DR severity per modified Davis staging
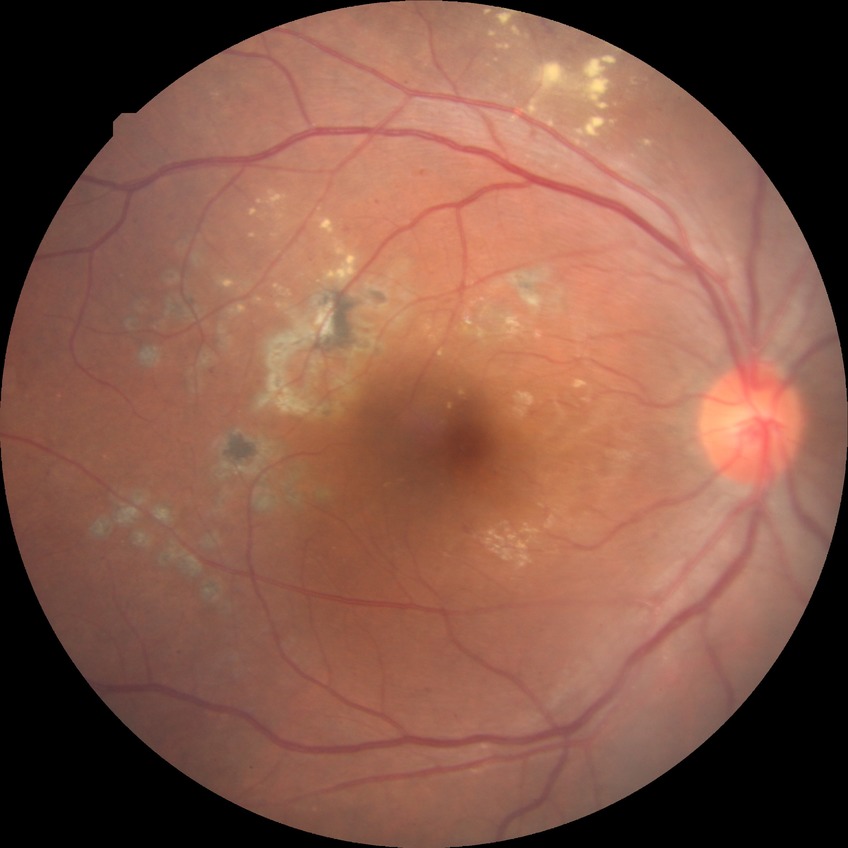
davis_grade: PDR